45-degree field of view; 2352 x 1568 pixels — 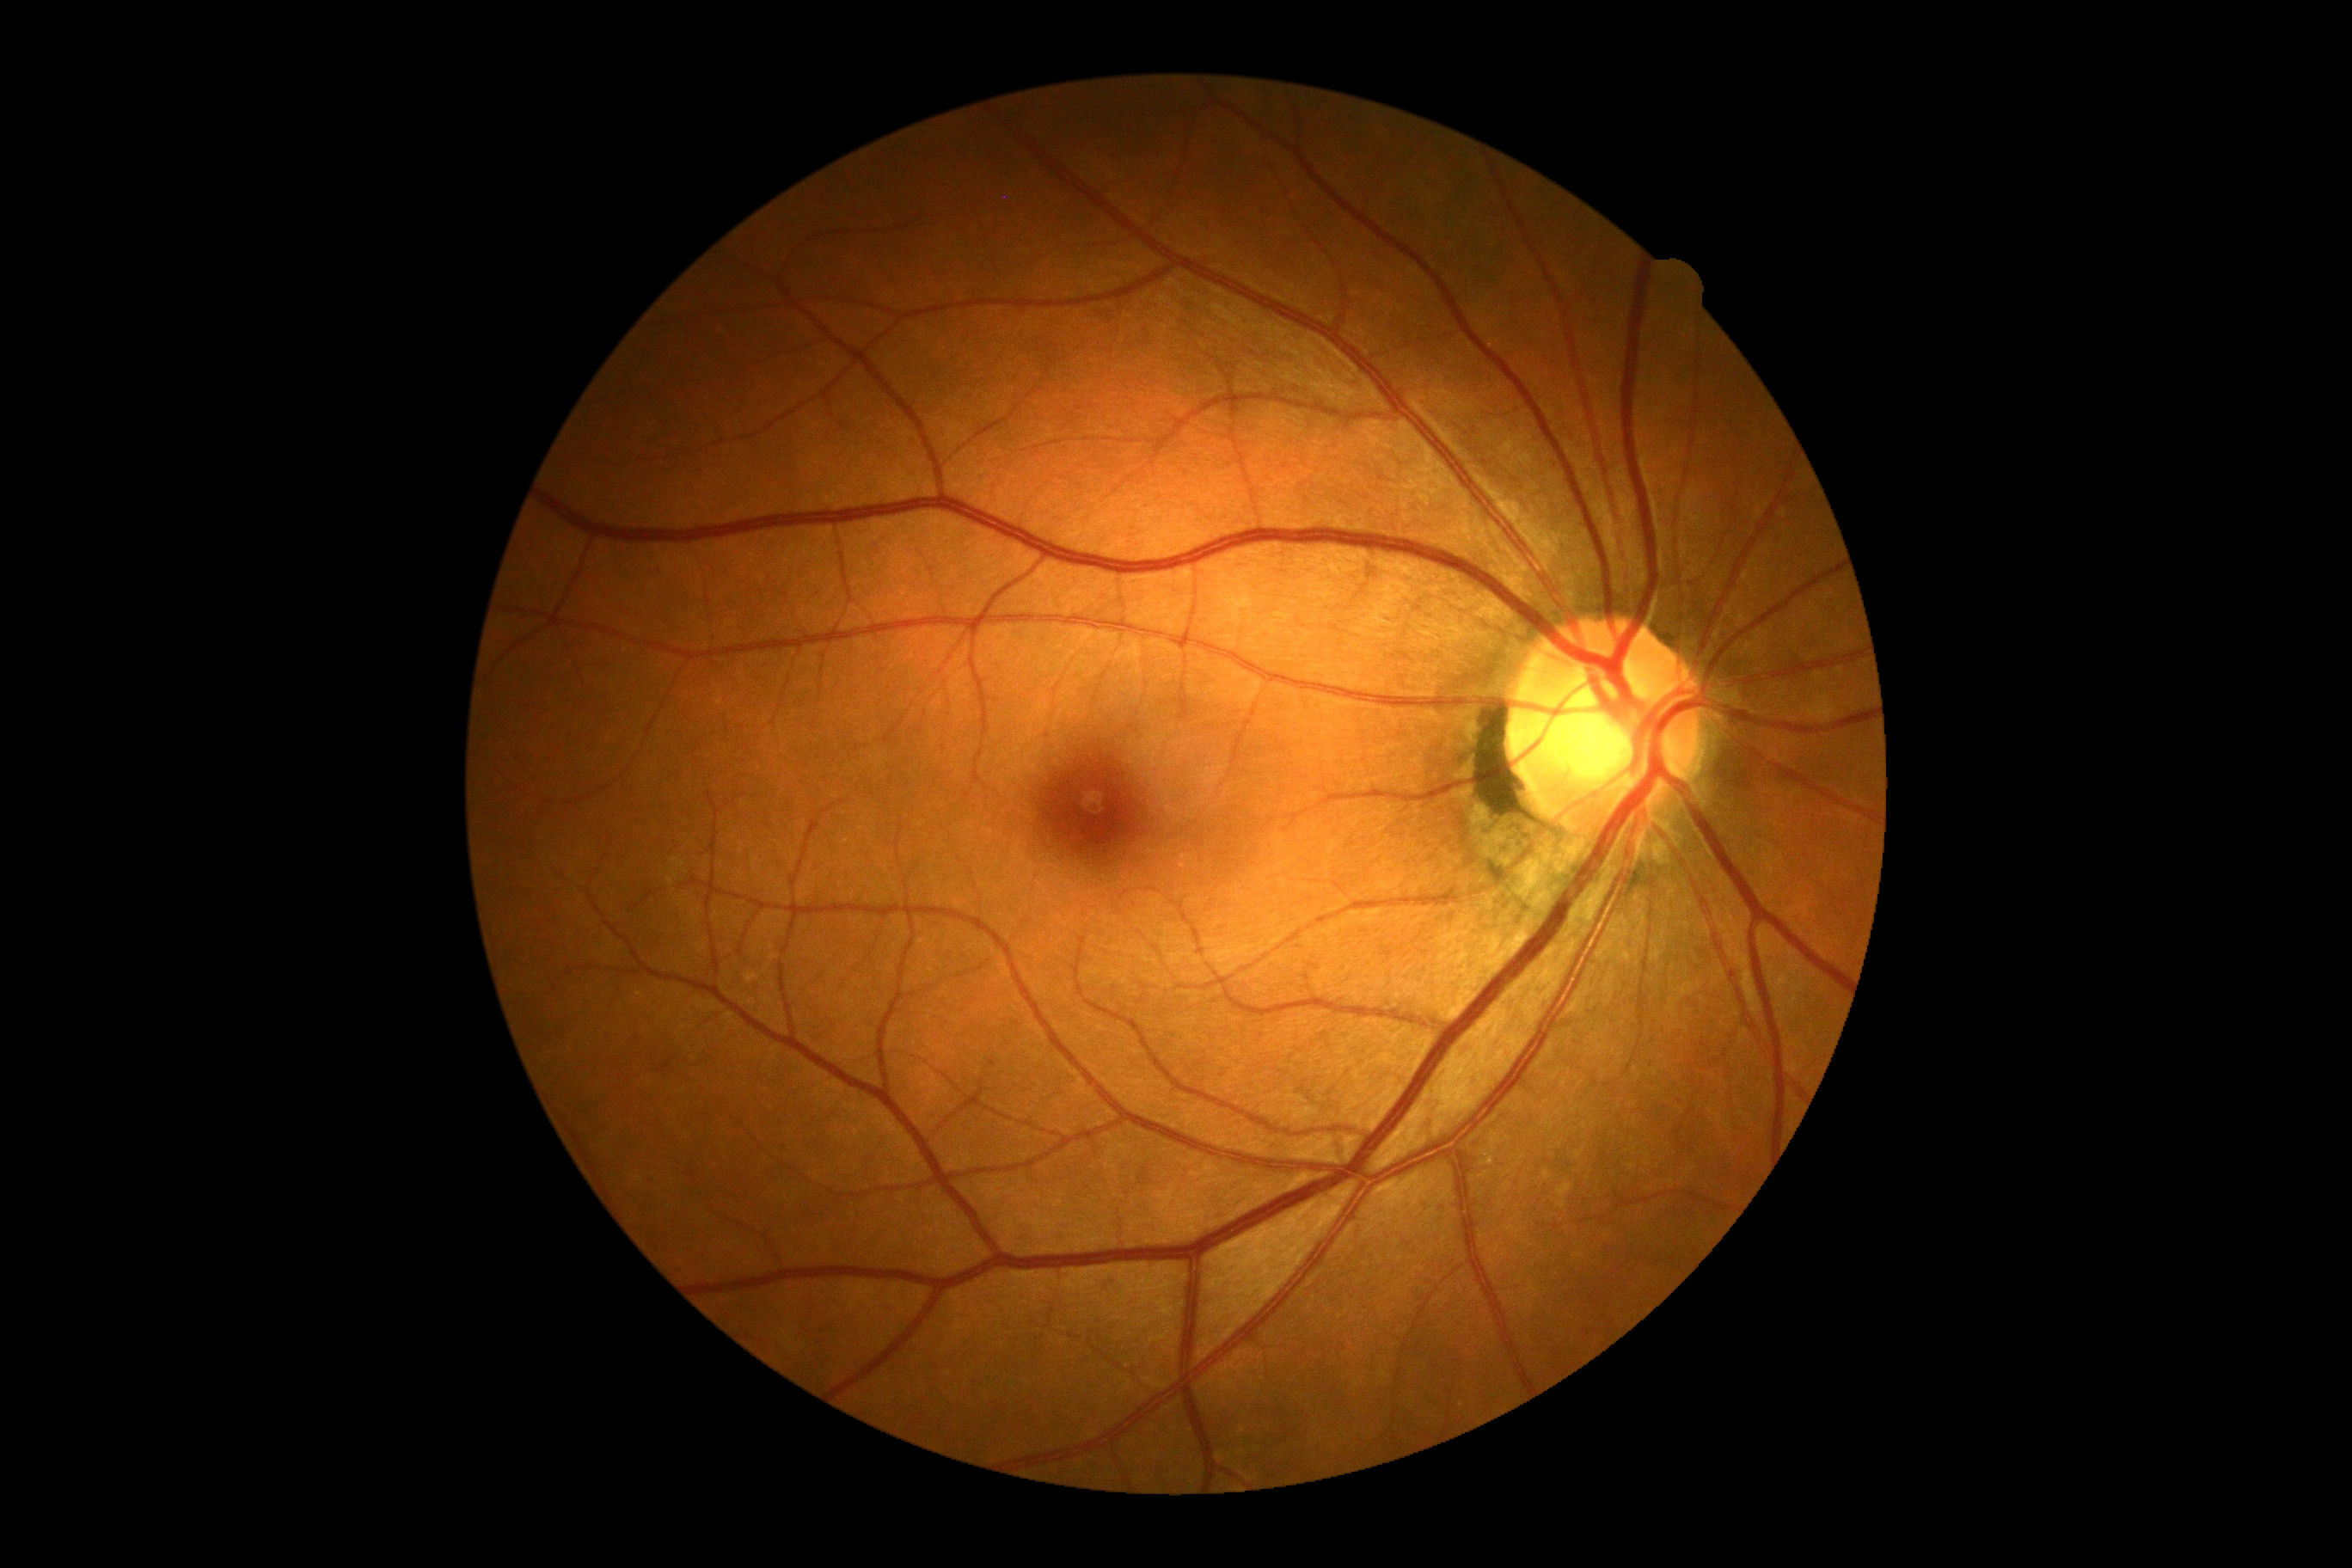 DR severity: grade 0 (no apparent retinopathy) | DR impression: no signs of DR.